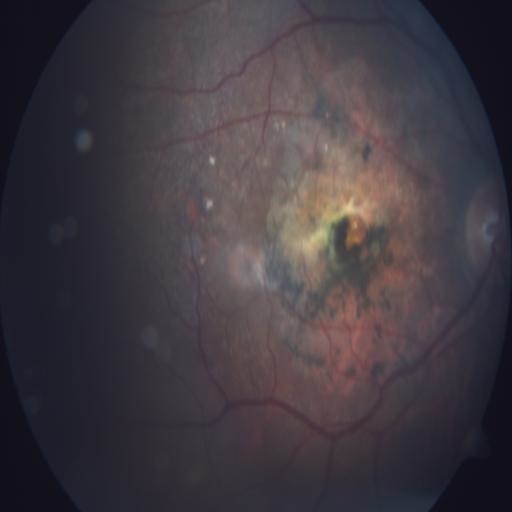
Findings: chorioretinitis (CRS).